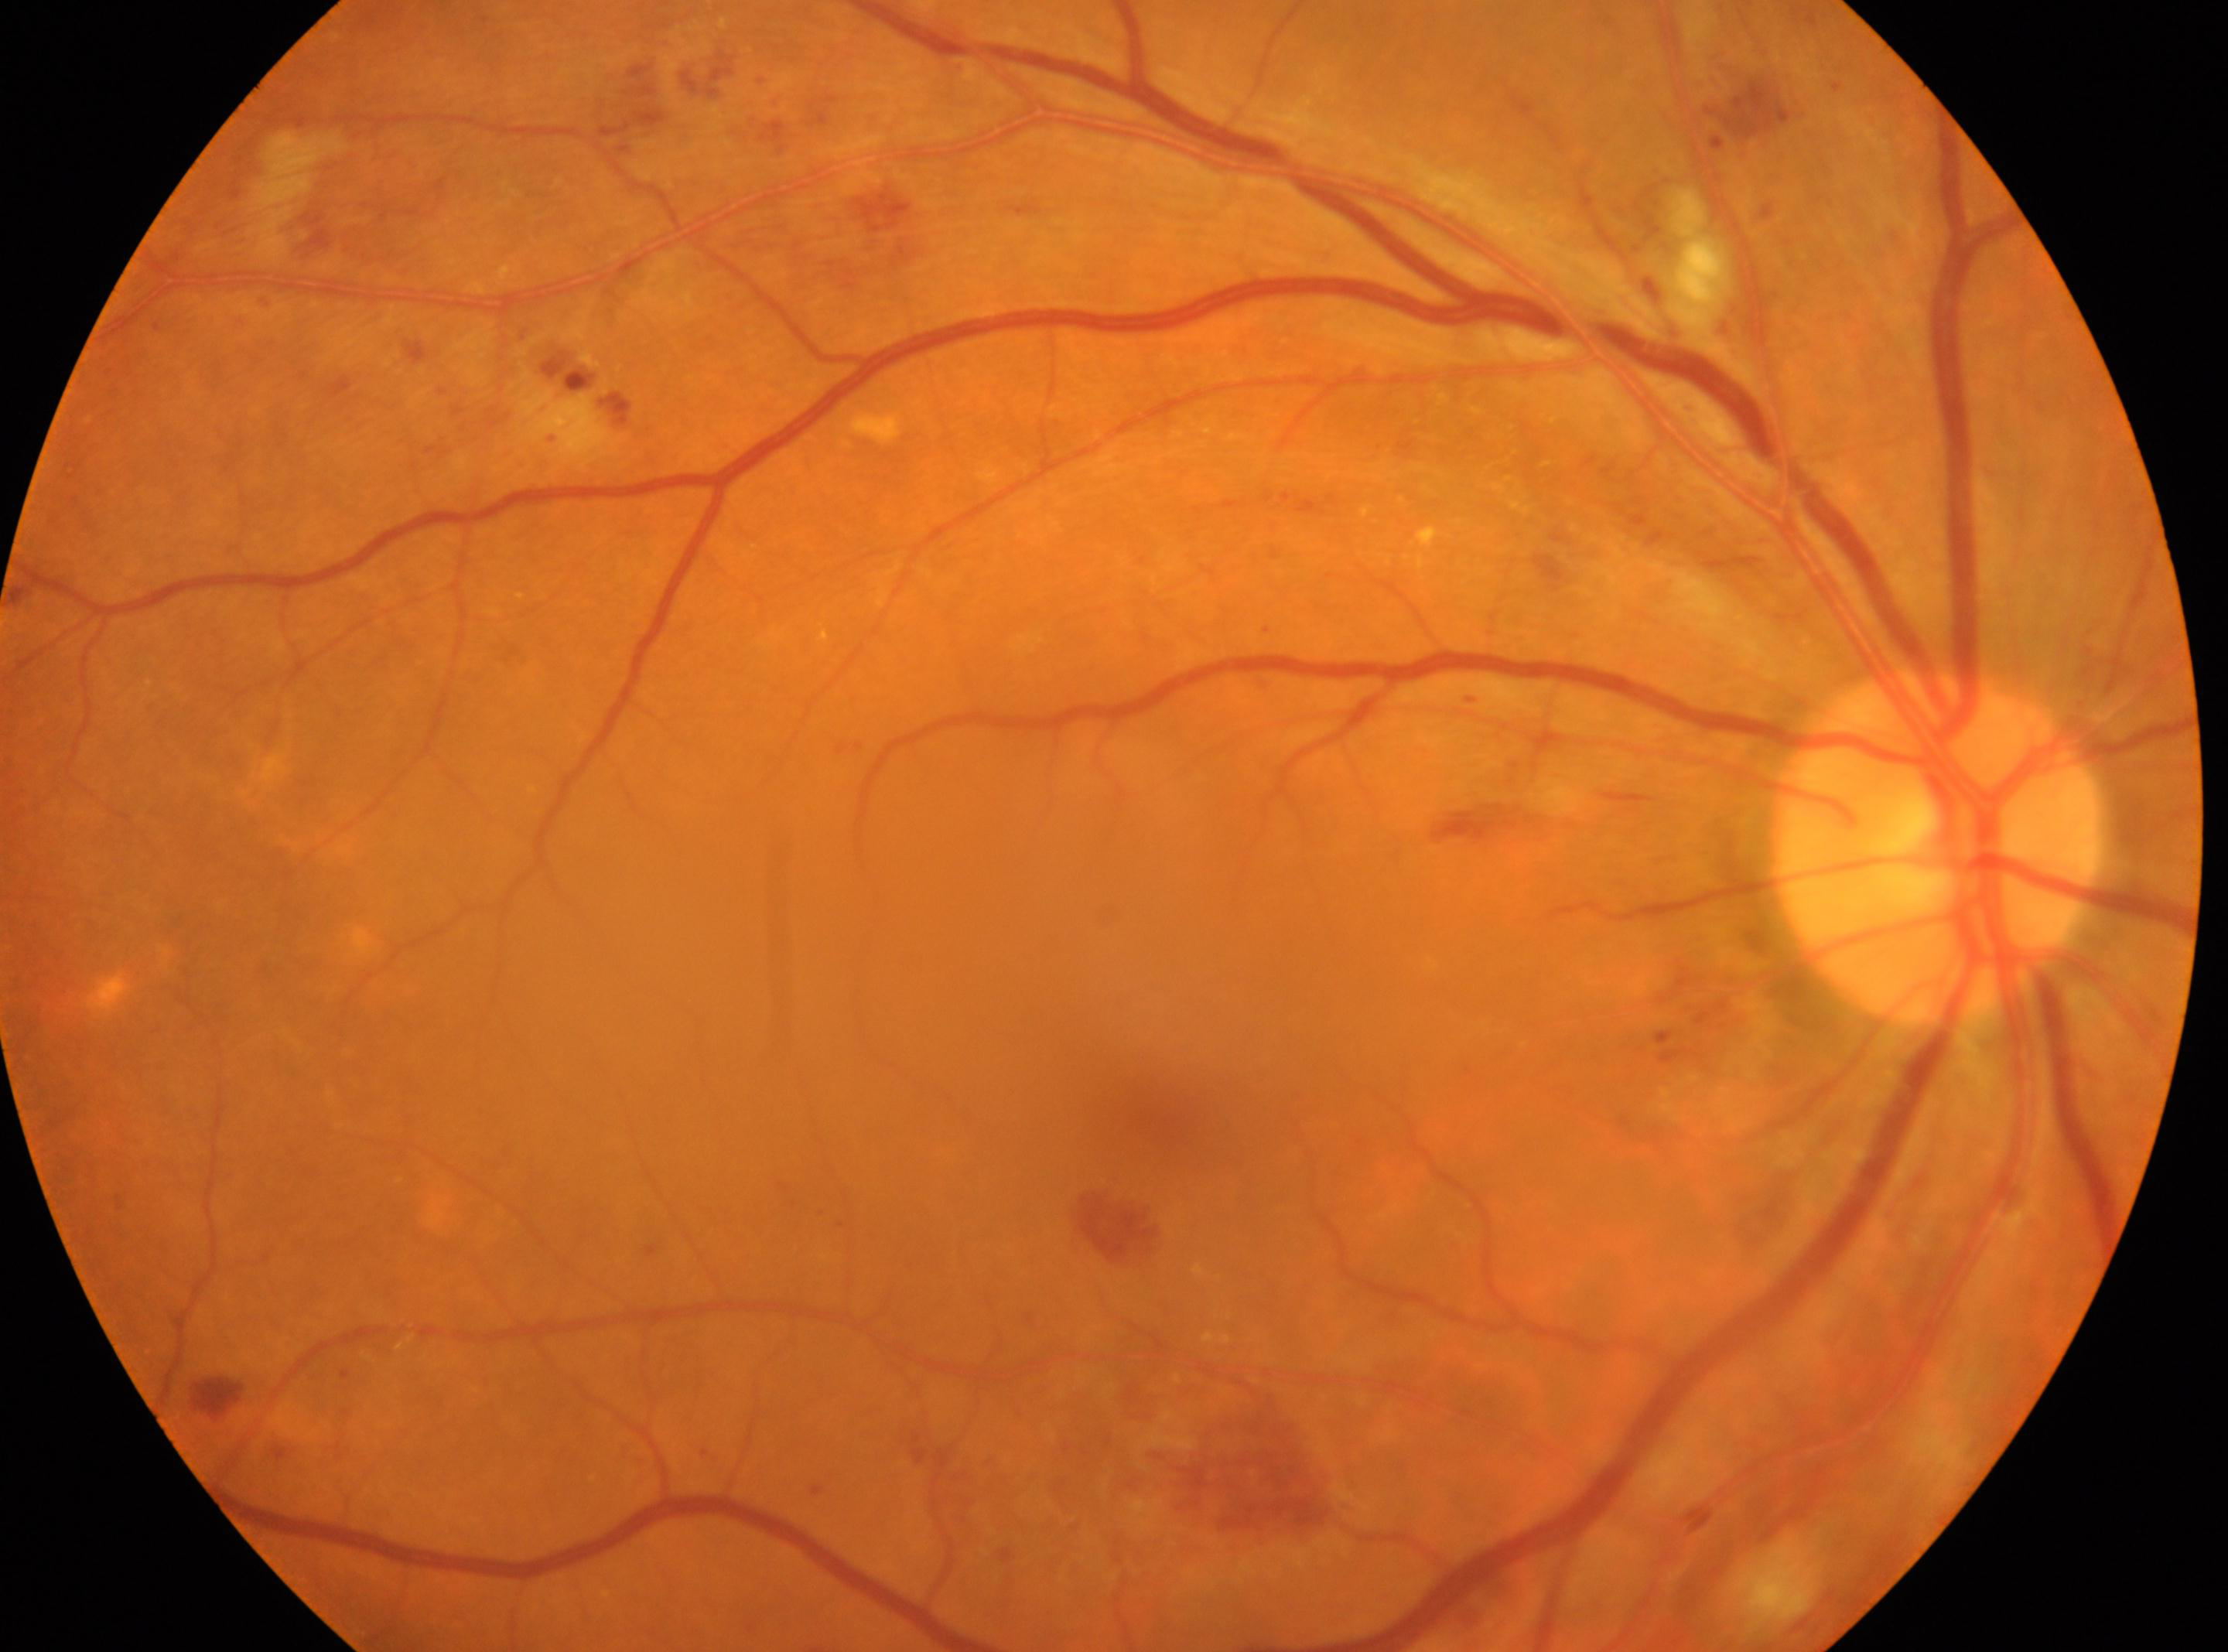

{"fovea": "(x: 1150, y: 1114)", "optic_disc": "(x: 1939, y: 845)", "eye": "OD", "dr_grade": "moderate non-proliferative diabetic retinopathy (grade 2)"}